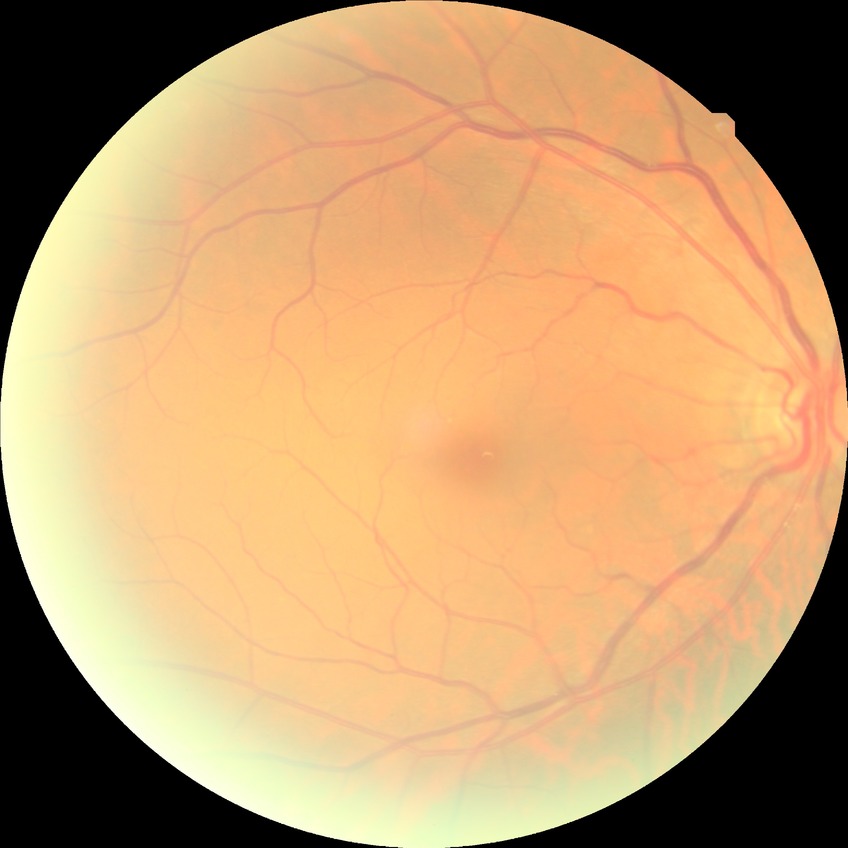

Diabetic retinopathy (DR) is no diabetic retinopathy (NDR).